Modified Davis classification — 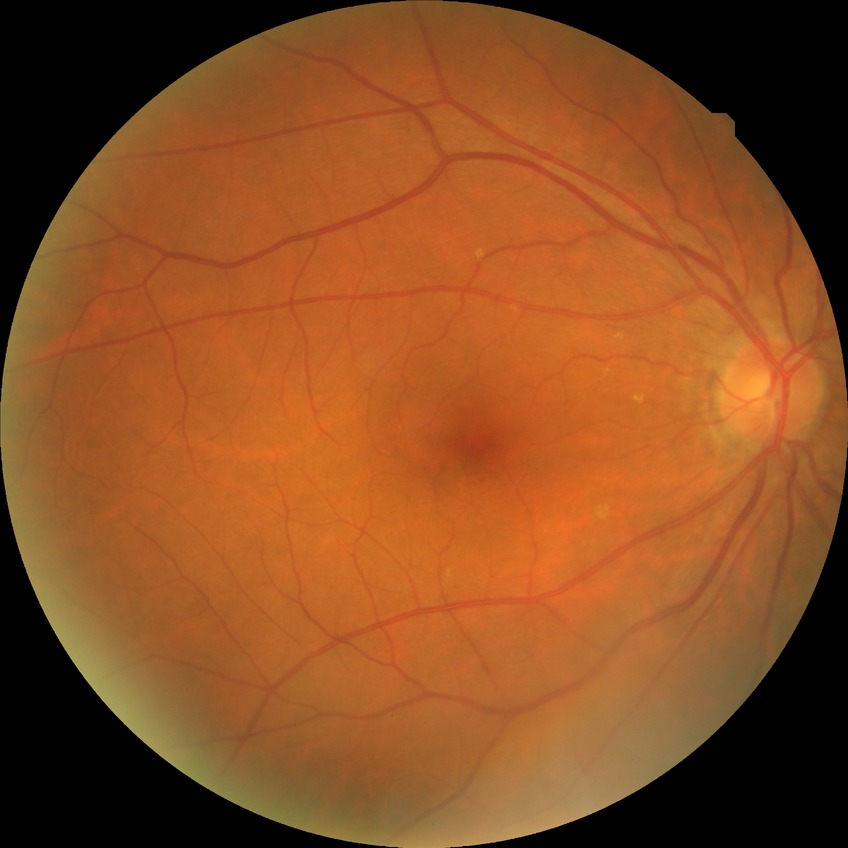
Diabetic retinopathy severity is simple diabetic retinopathy.